Fundus photo. FOV: 50 degrees. Image size 2228x1652.
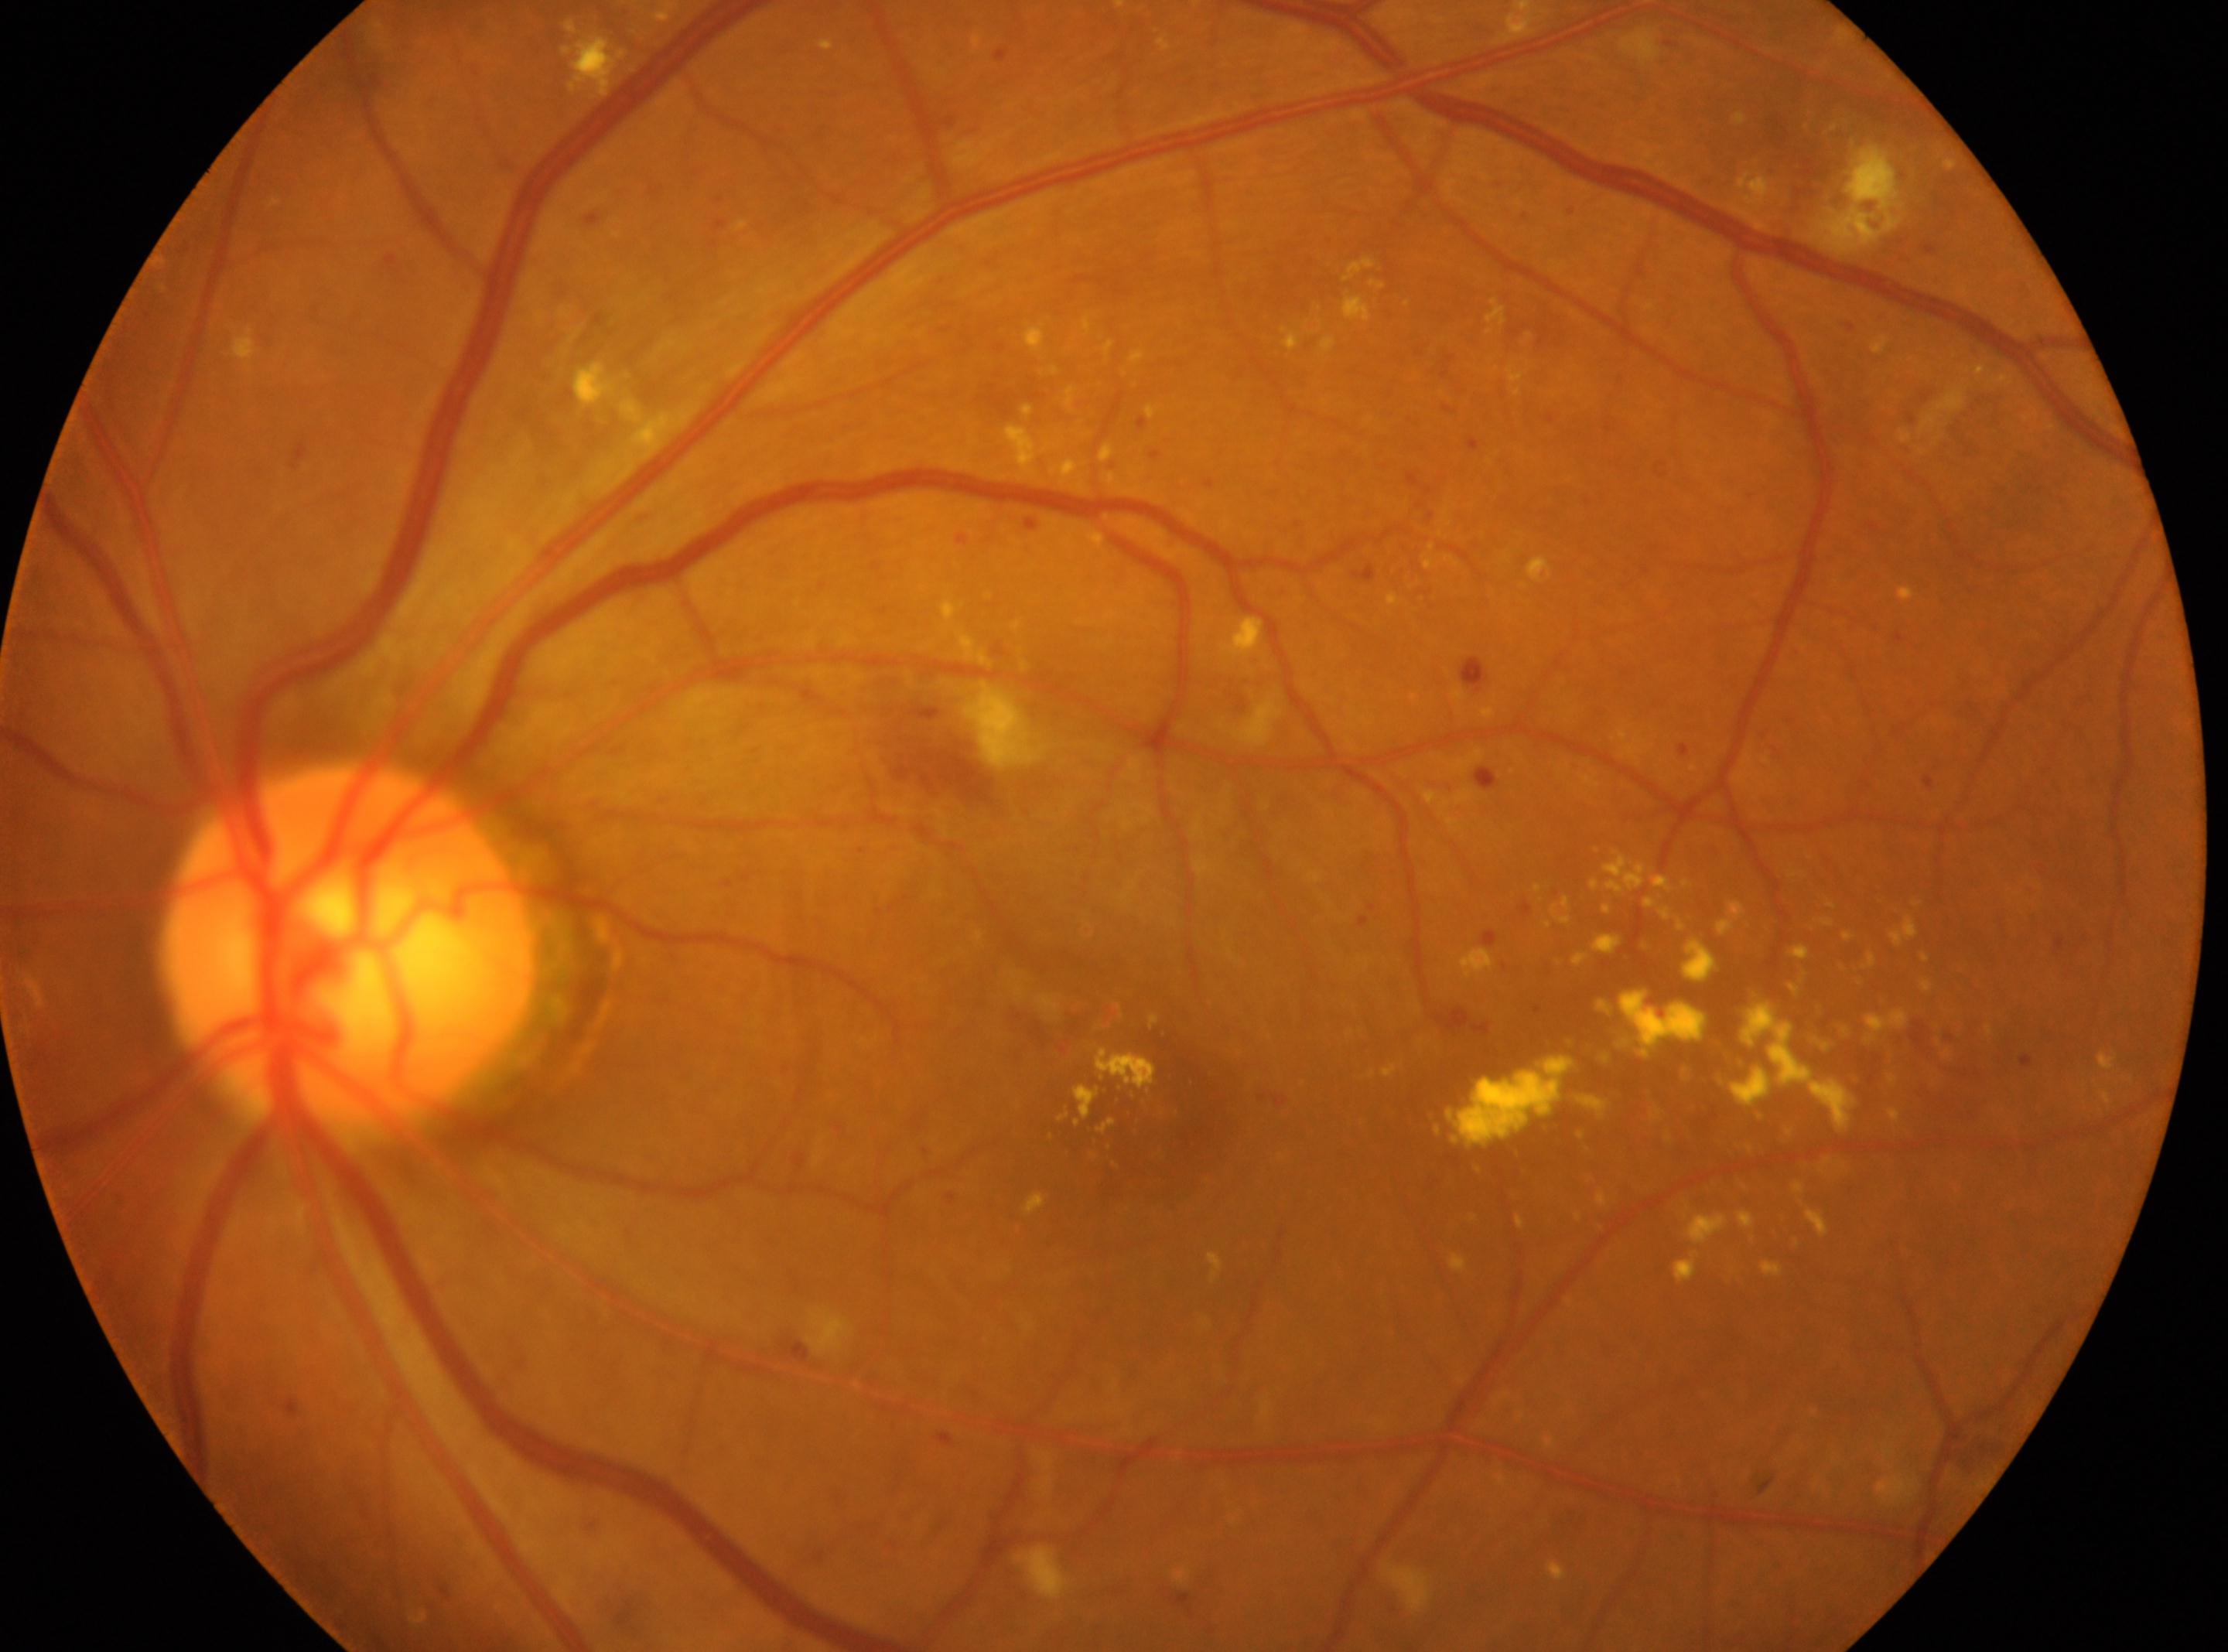
Imaged eye: OS. DR class: non-proliferative diabetic retinopathy. The optic nerve head is at x=348, y=948. DR stage: grade 3 (severe NPDR). The fovea is at x=1164, y=1117.